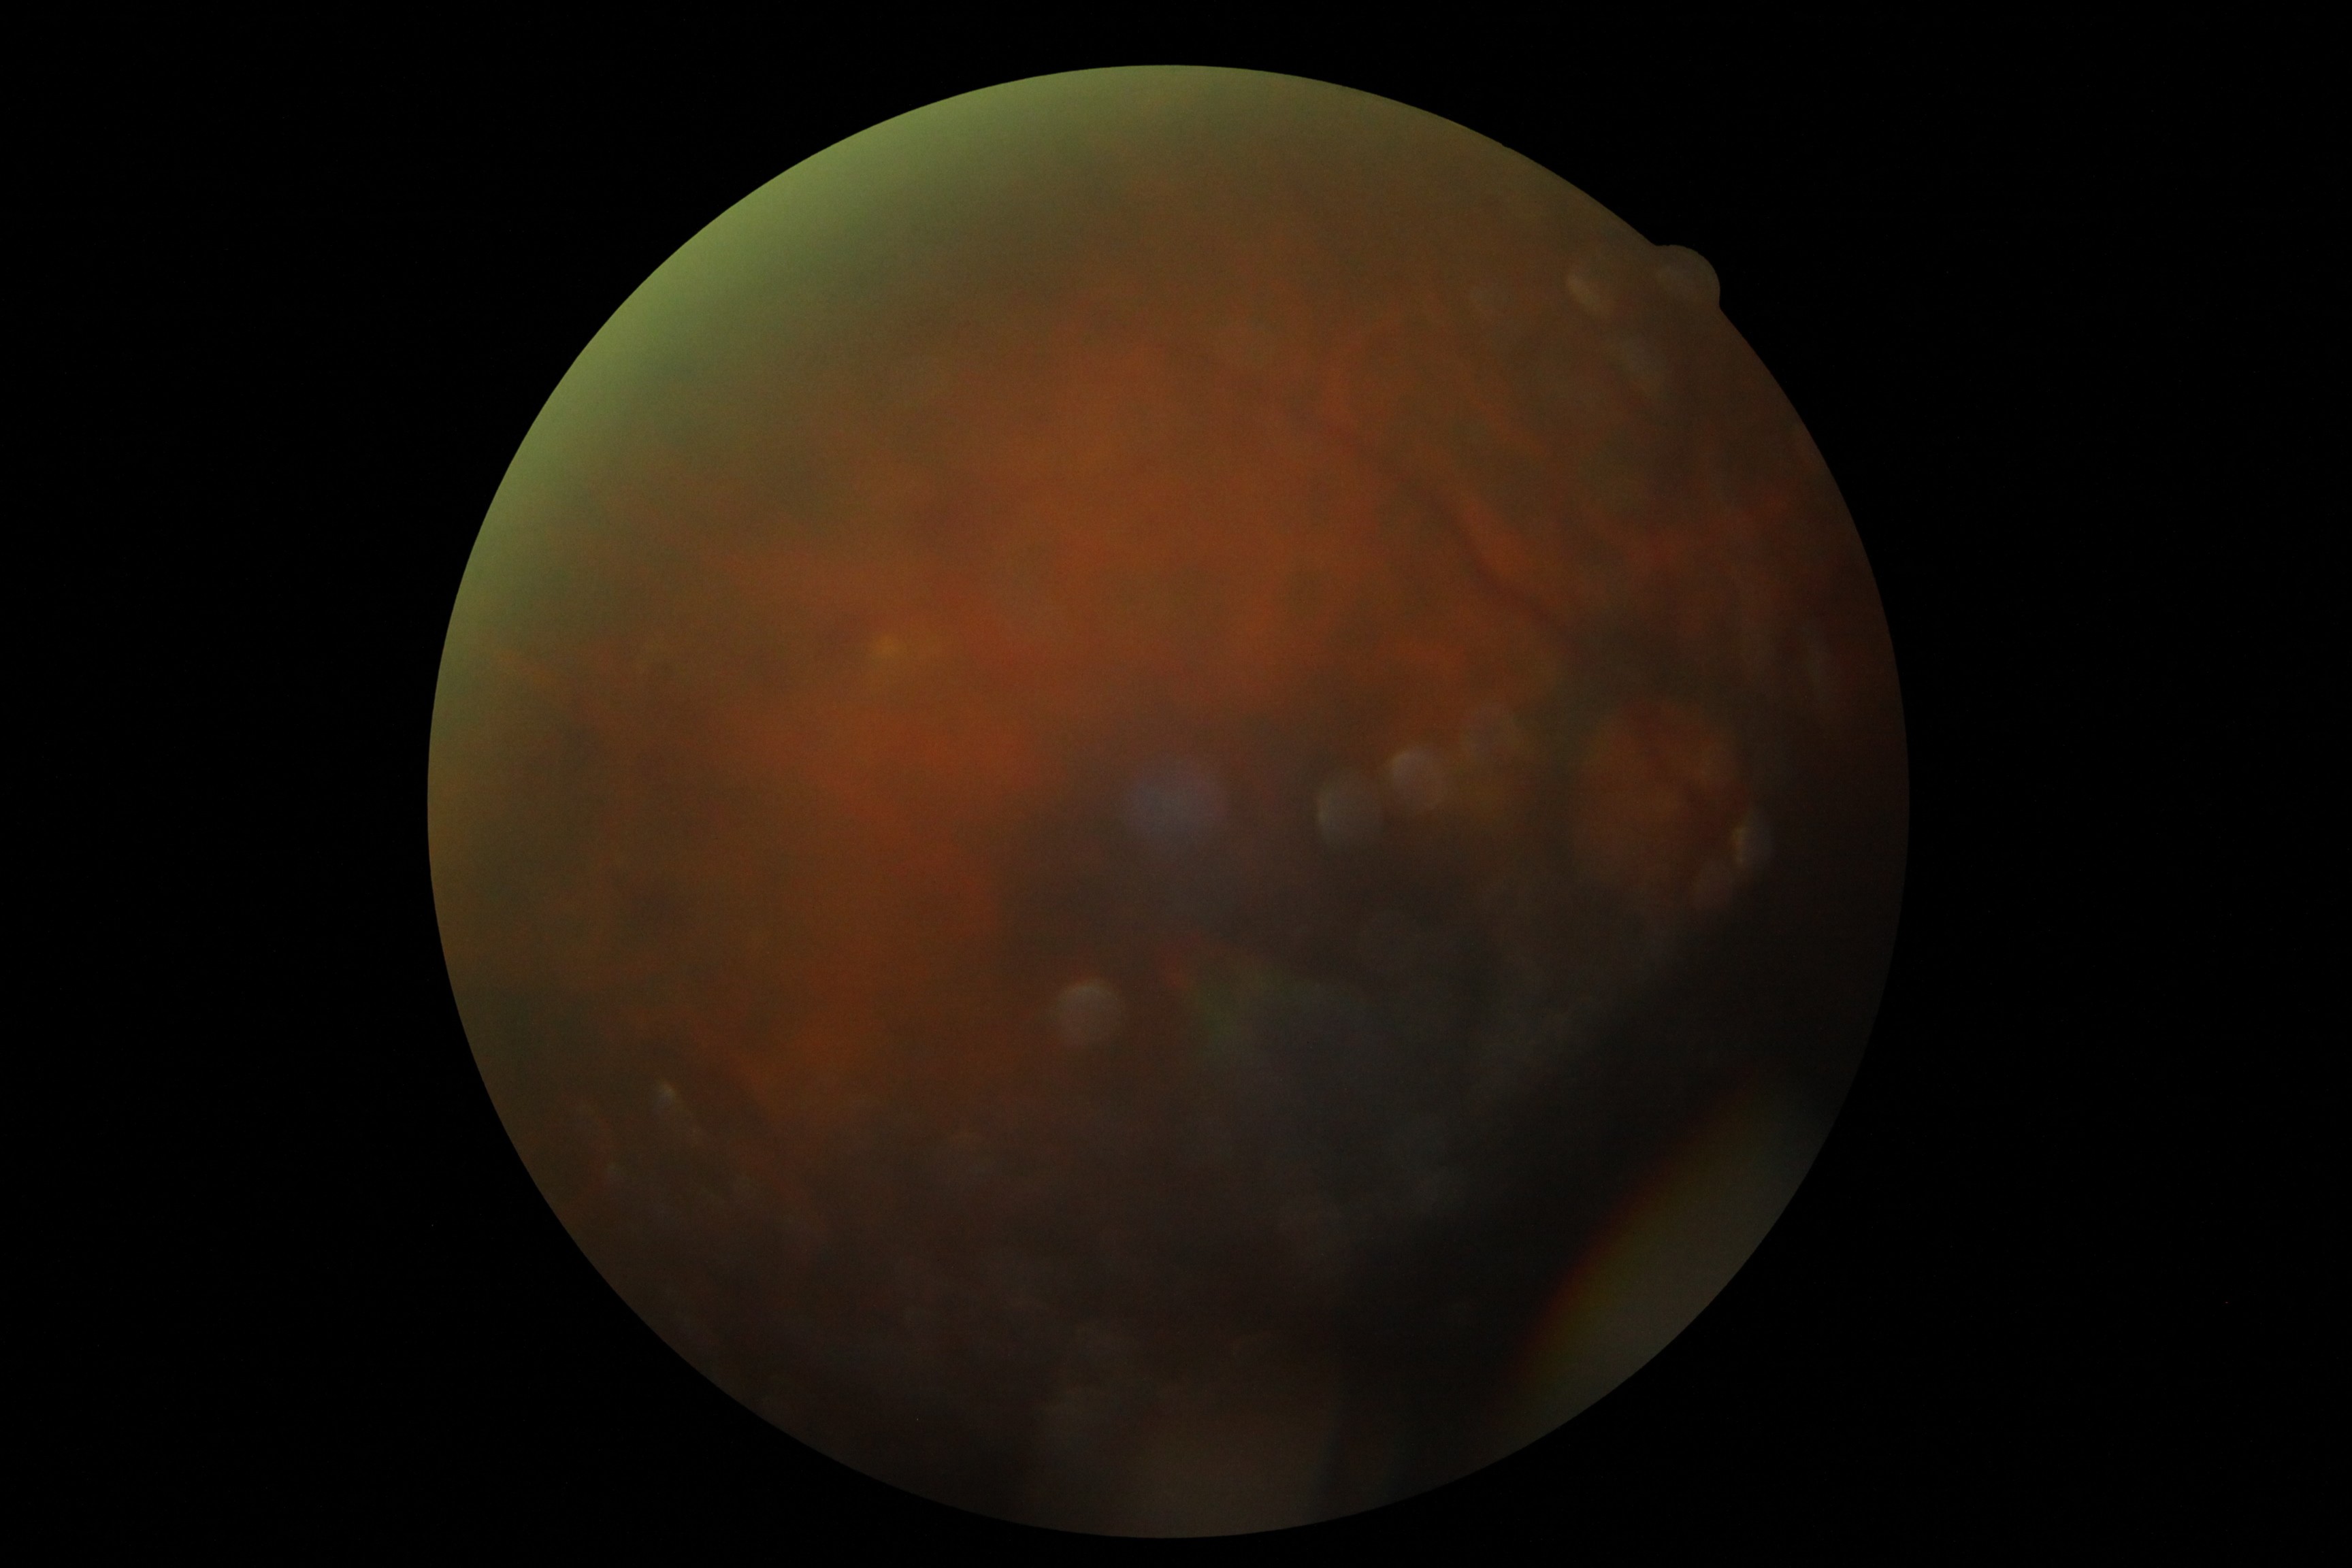 DR severity: grade 2 — more than just microaneurysms but less than severe NPDR.